Color fundus photograph · acquired with a NIDEK AFC-230 · 848x848: 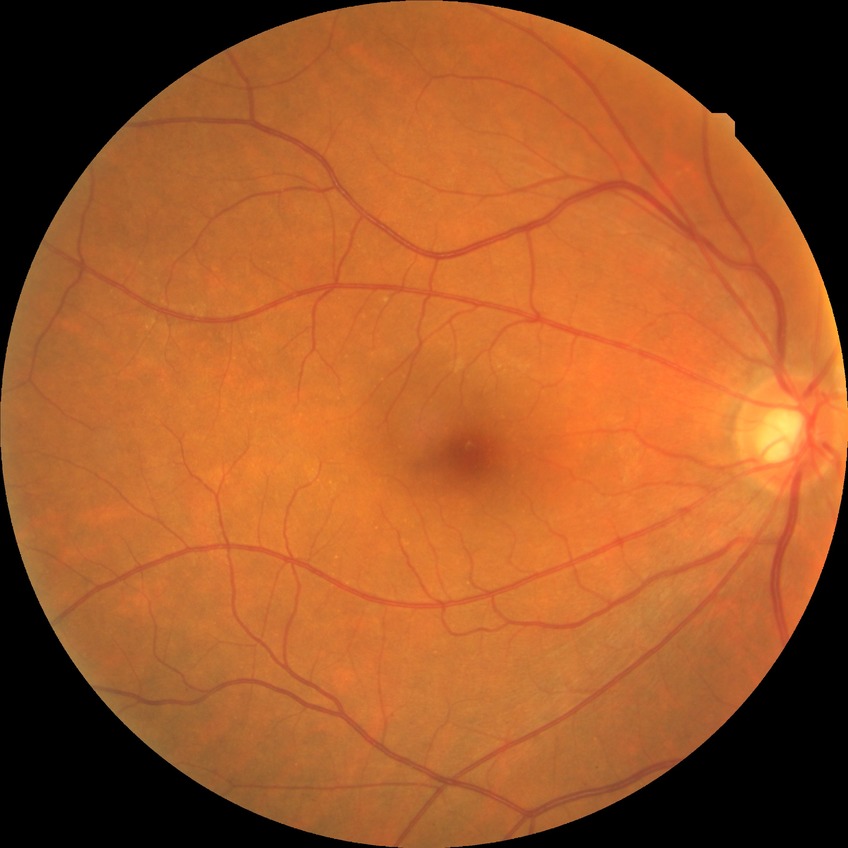

Davis stage: NDR. No diabetic retinal disease findings.